512x512px — 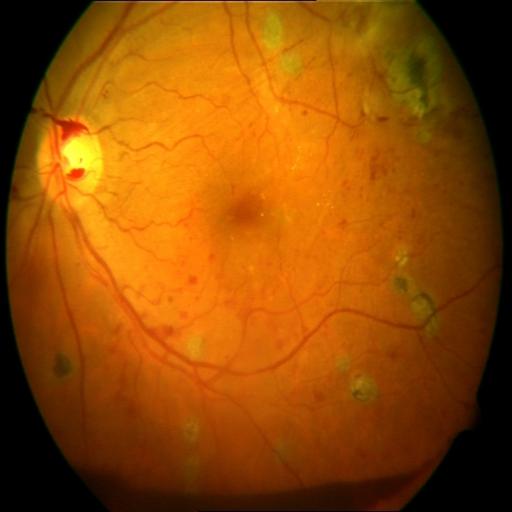 Impression (2):
- laser scars (LS)
- optociliary shunt (ST)